Image size 640x480. Wide-field fundus photograph from neonatal ROP screening. Clarity RetCam 3, 130° FOV:
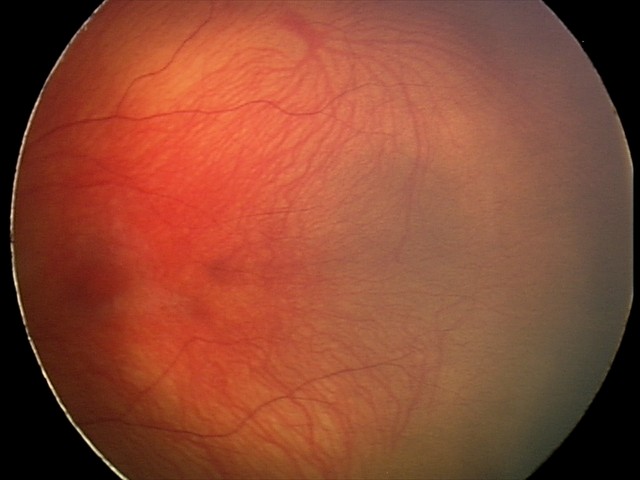 From an examination with diagnosis of status post retinopathy of prematurity.